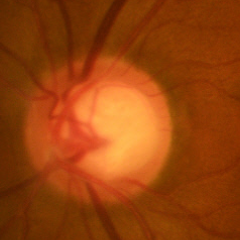 Findings consistent with early glaucoma. (Criteria: glaucomatous retinal nerve fiber layer defects on red-free fundus photography without visual field defects.)